No pharmacologic dilation; color fundus photograph; camera: NIDEK AFC-230; 848 x 848 pixels: 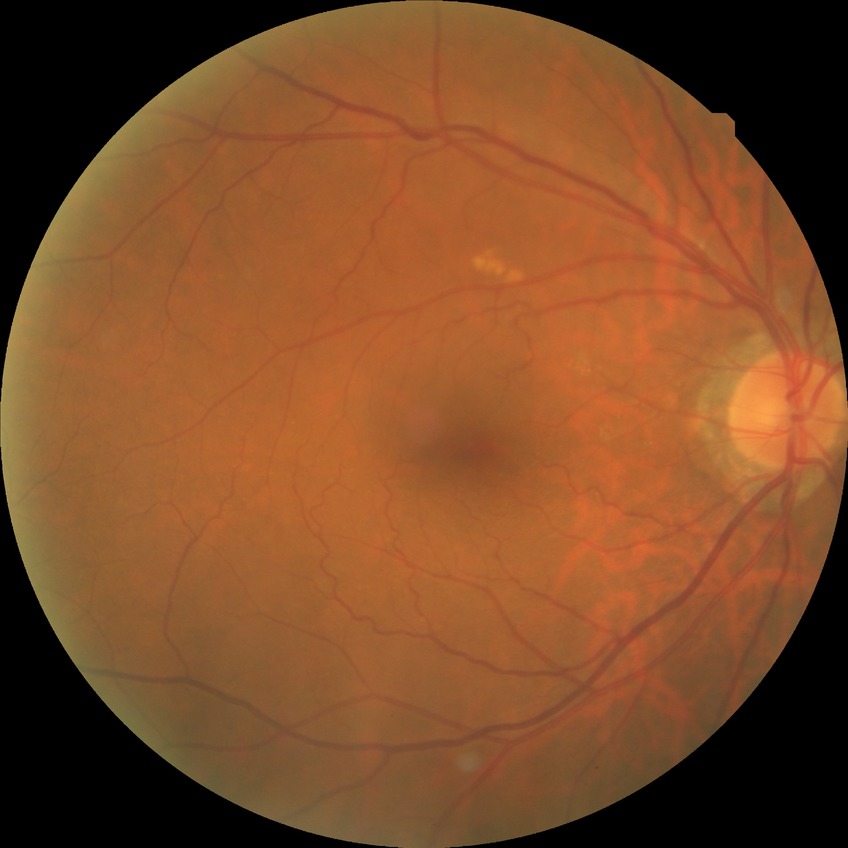

diabetic retinopathy (DR): no diabetic retinopathy (NDR).